Color fundus photograph:
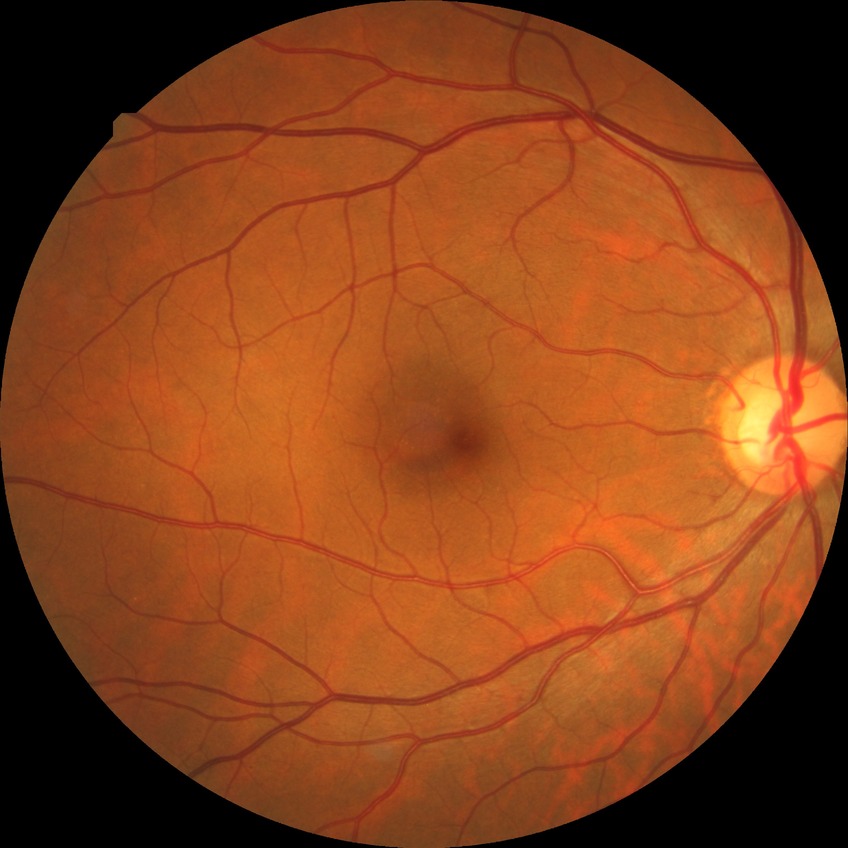

{
  "davis_grade": "no diabetic retinopathy (NDR)"
}